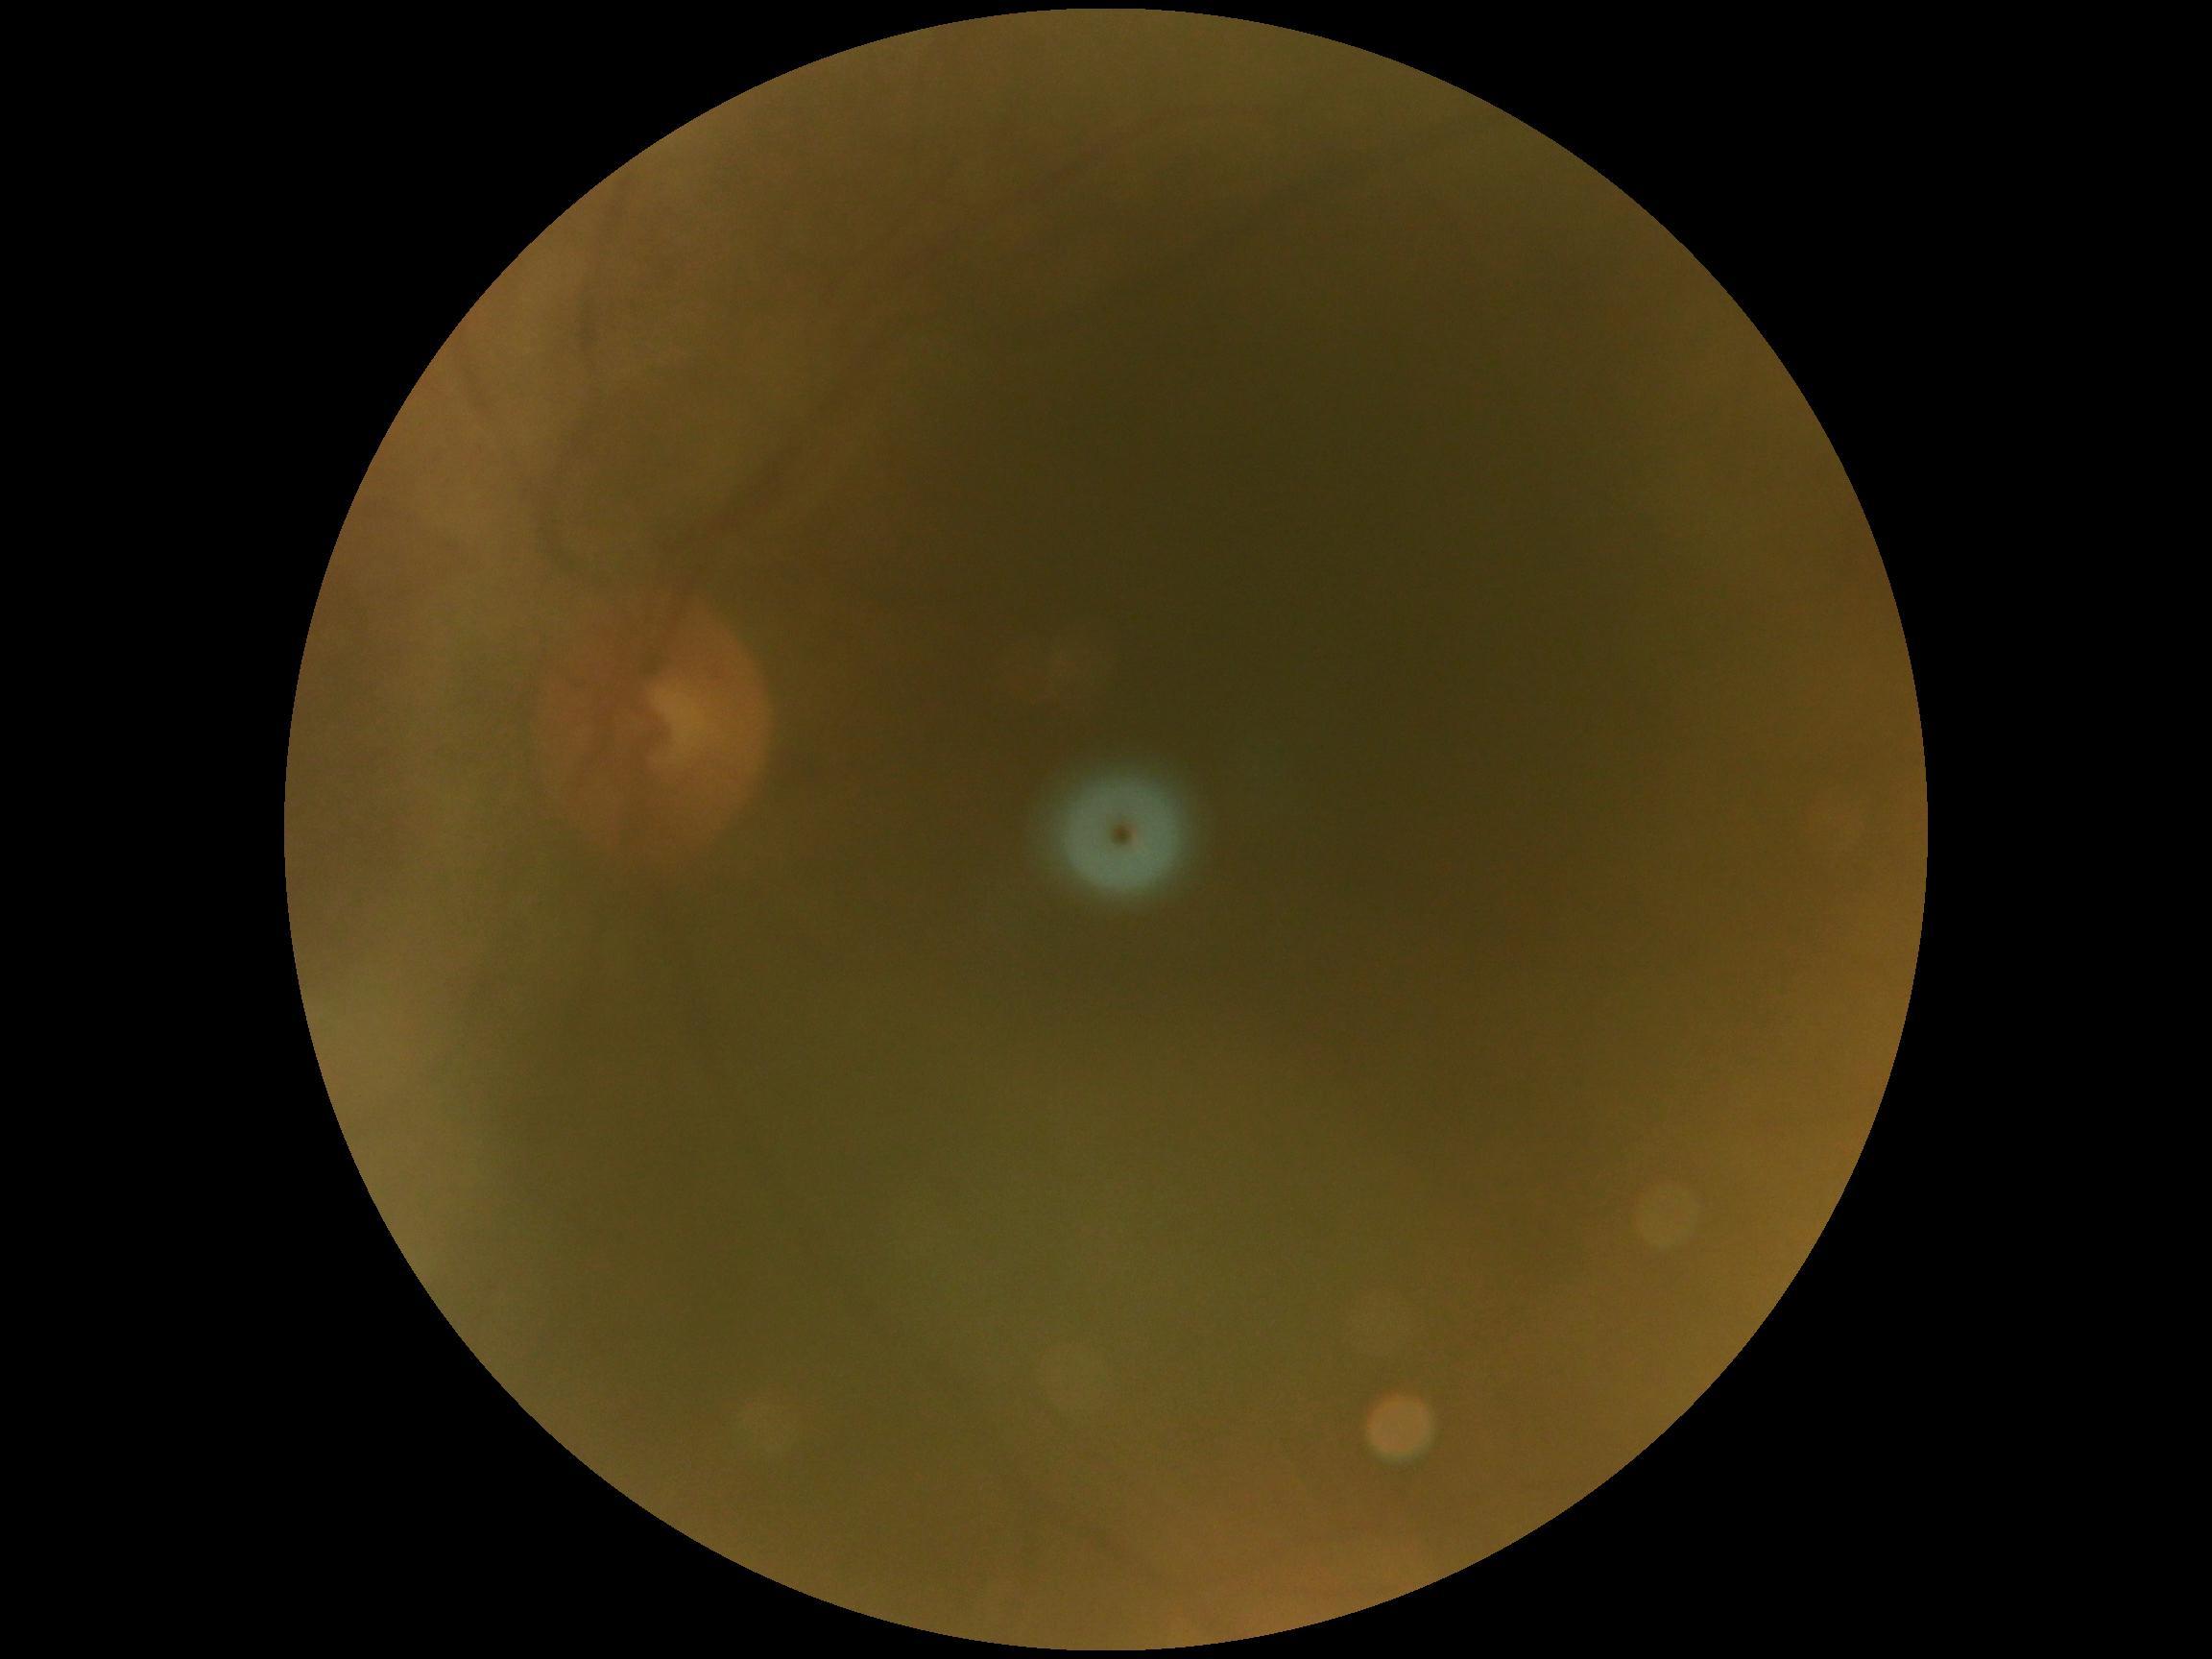 retinopathy grade@ungradable; image quality@insufficient.